Mydriatic (tropicamide and phenylephrine), fundus photo, 2228x1652, posterior pole field covering the optic disc and macula.
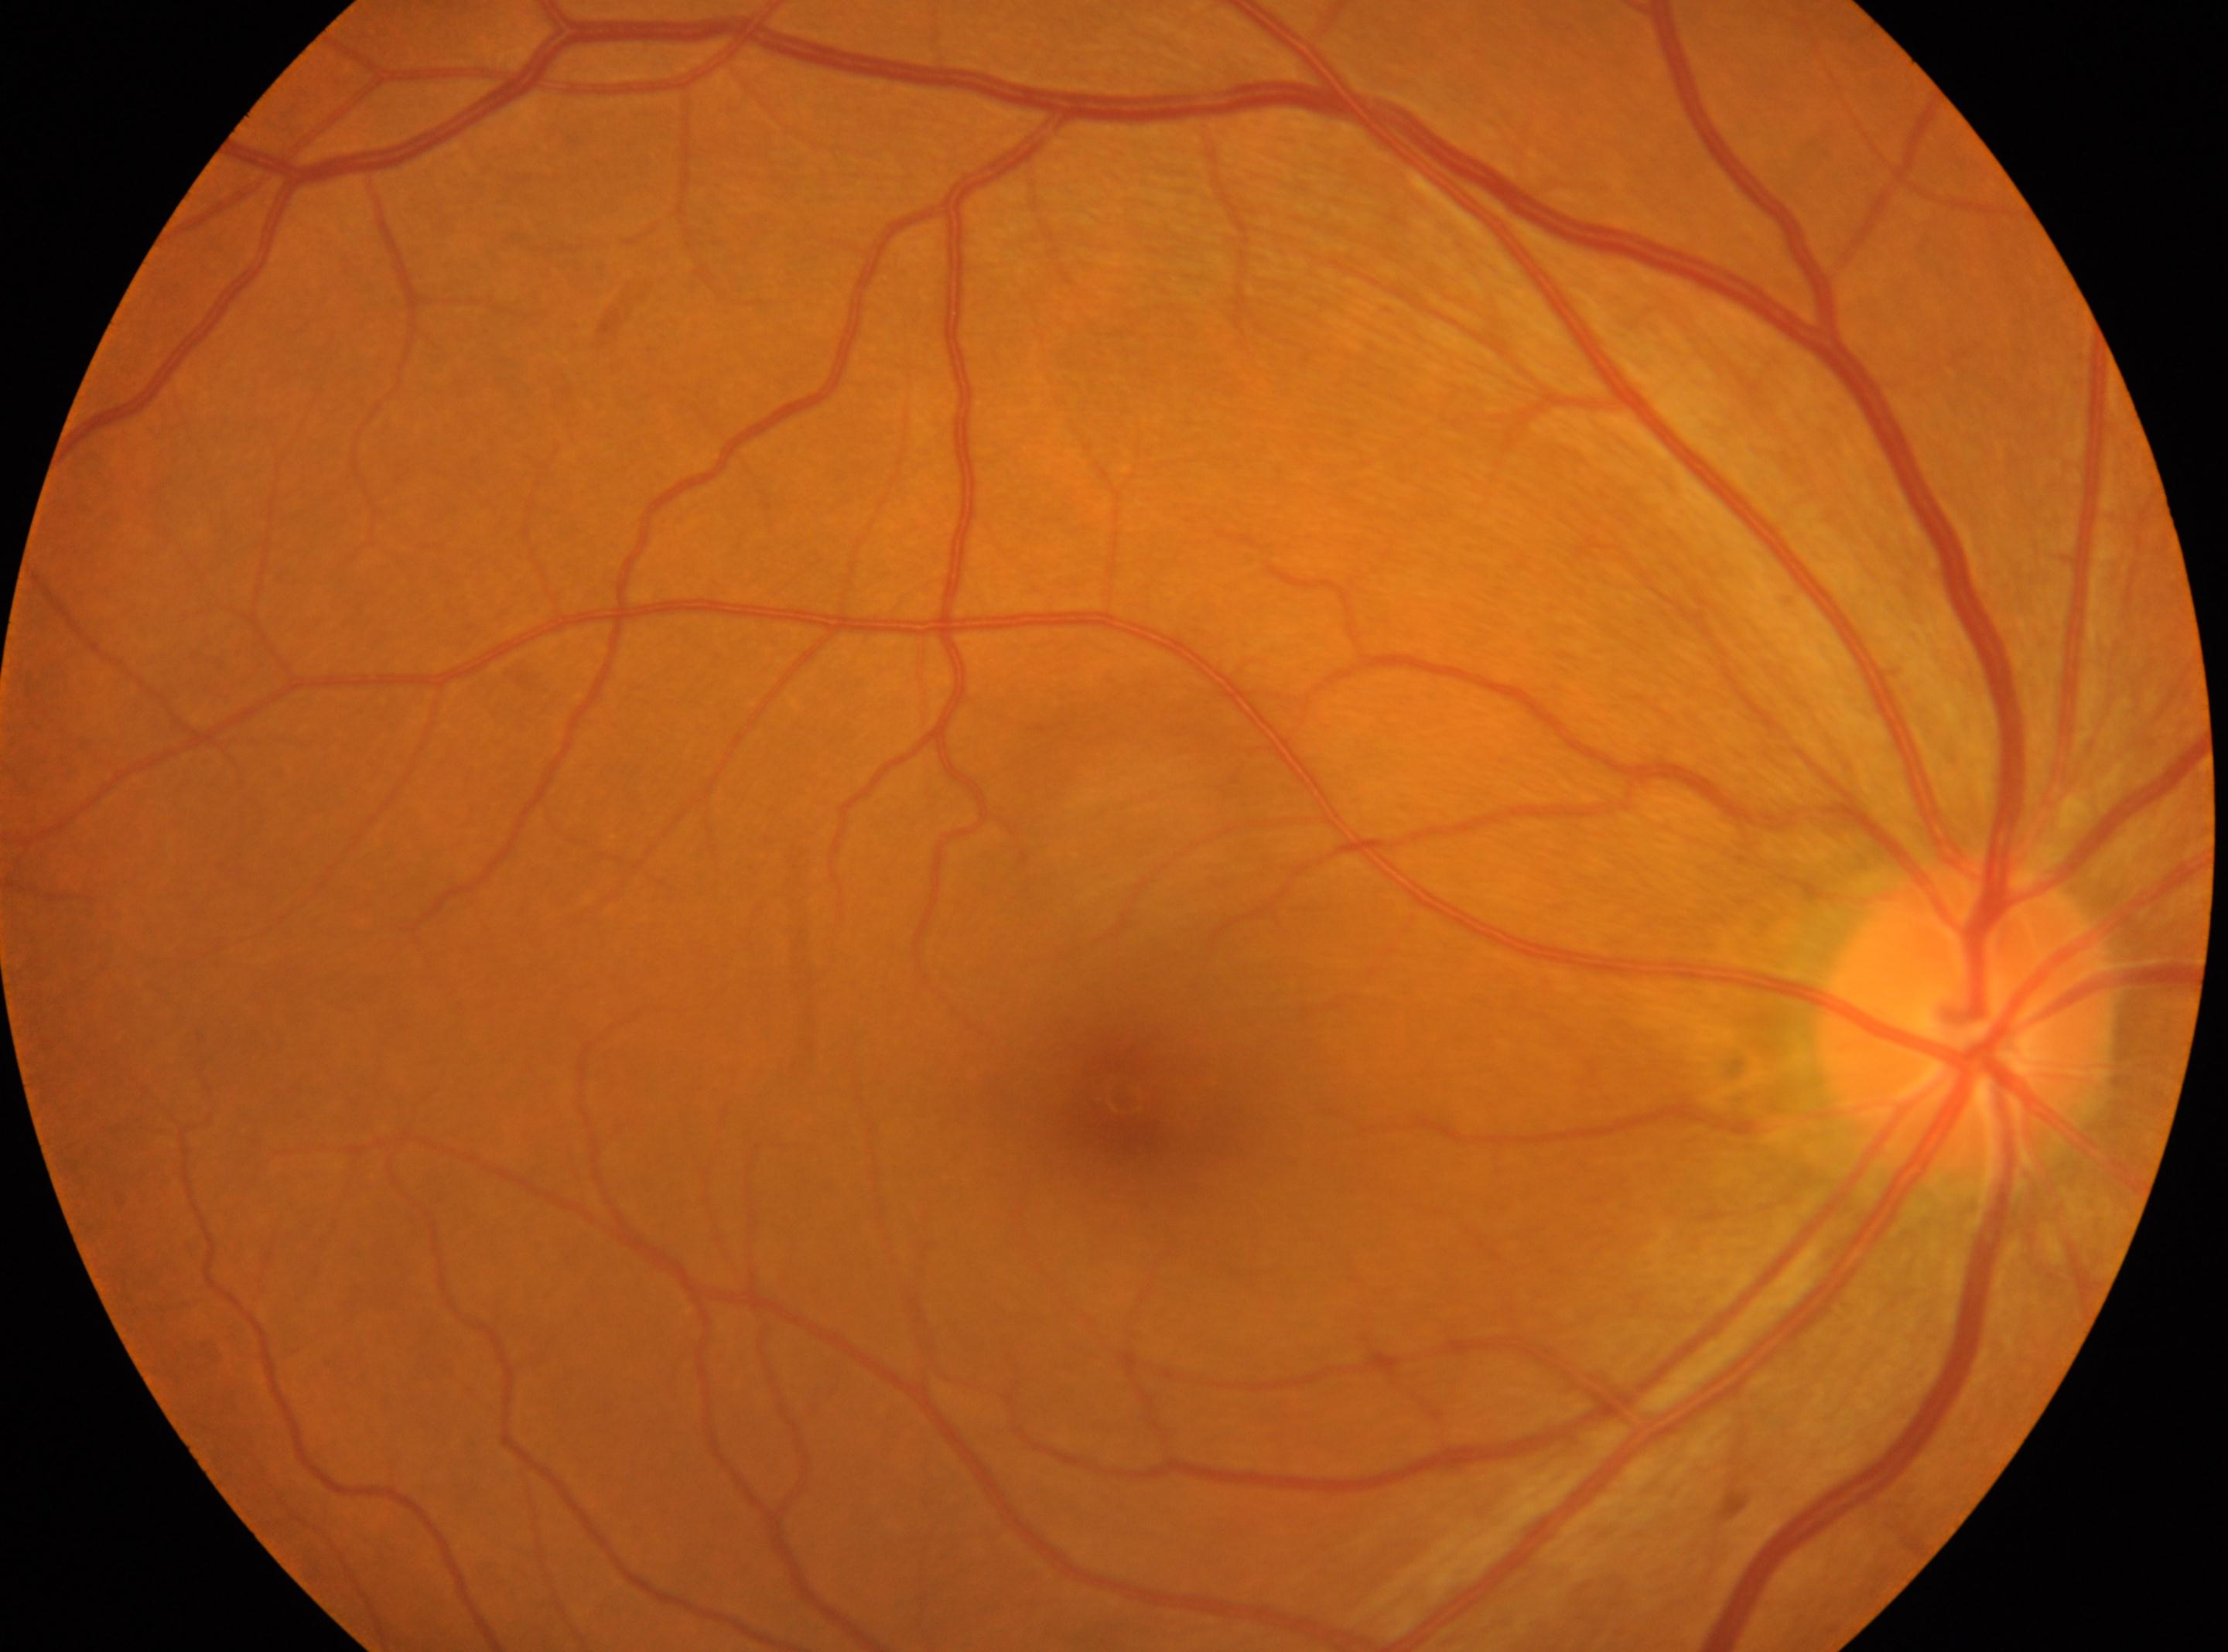

Disc center: x=1966, y=1016.
The image shows the right eye.
Diabetic retinopathy severity is 0 — no visible signs of diabetic retinopathy.
Fovea: x=1123, y=1098.